FOV: 45 degrees; CFP; image size 2352x1568
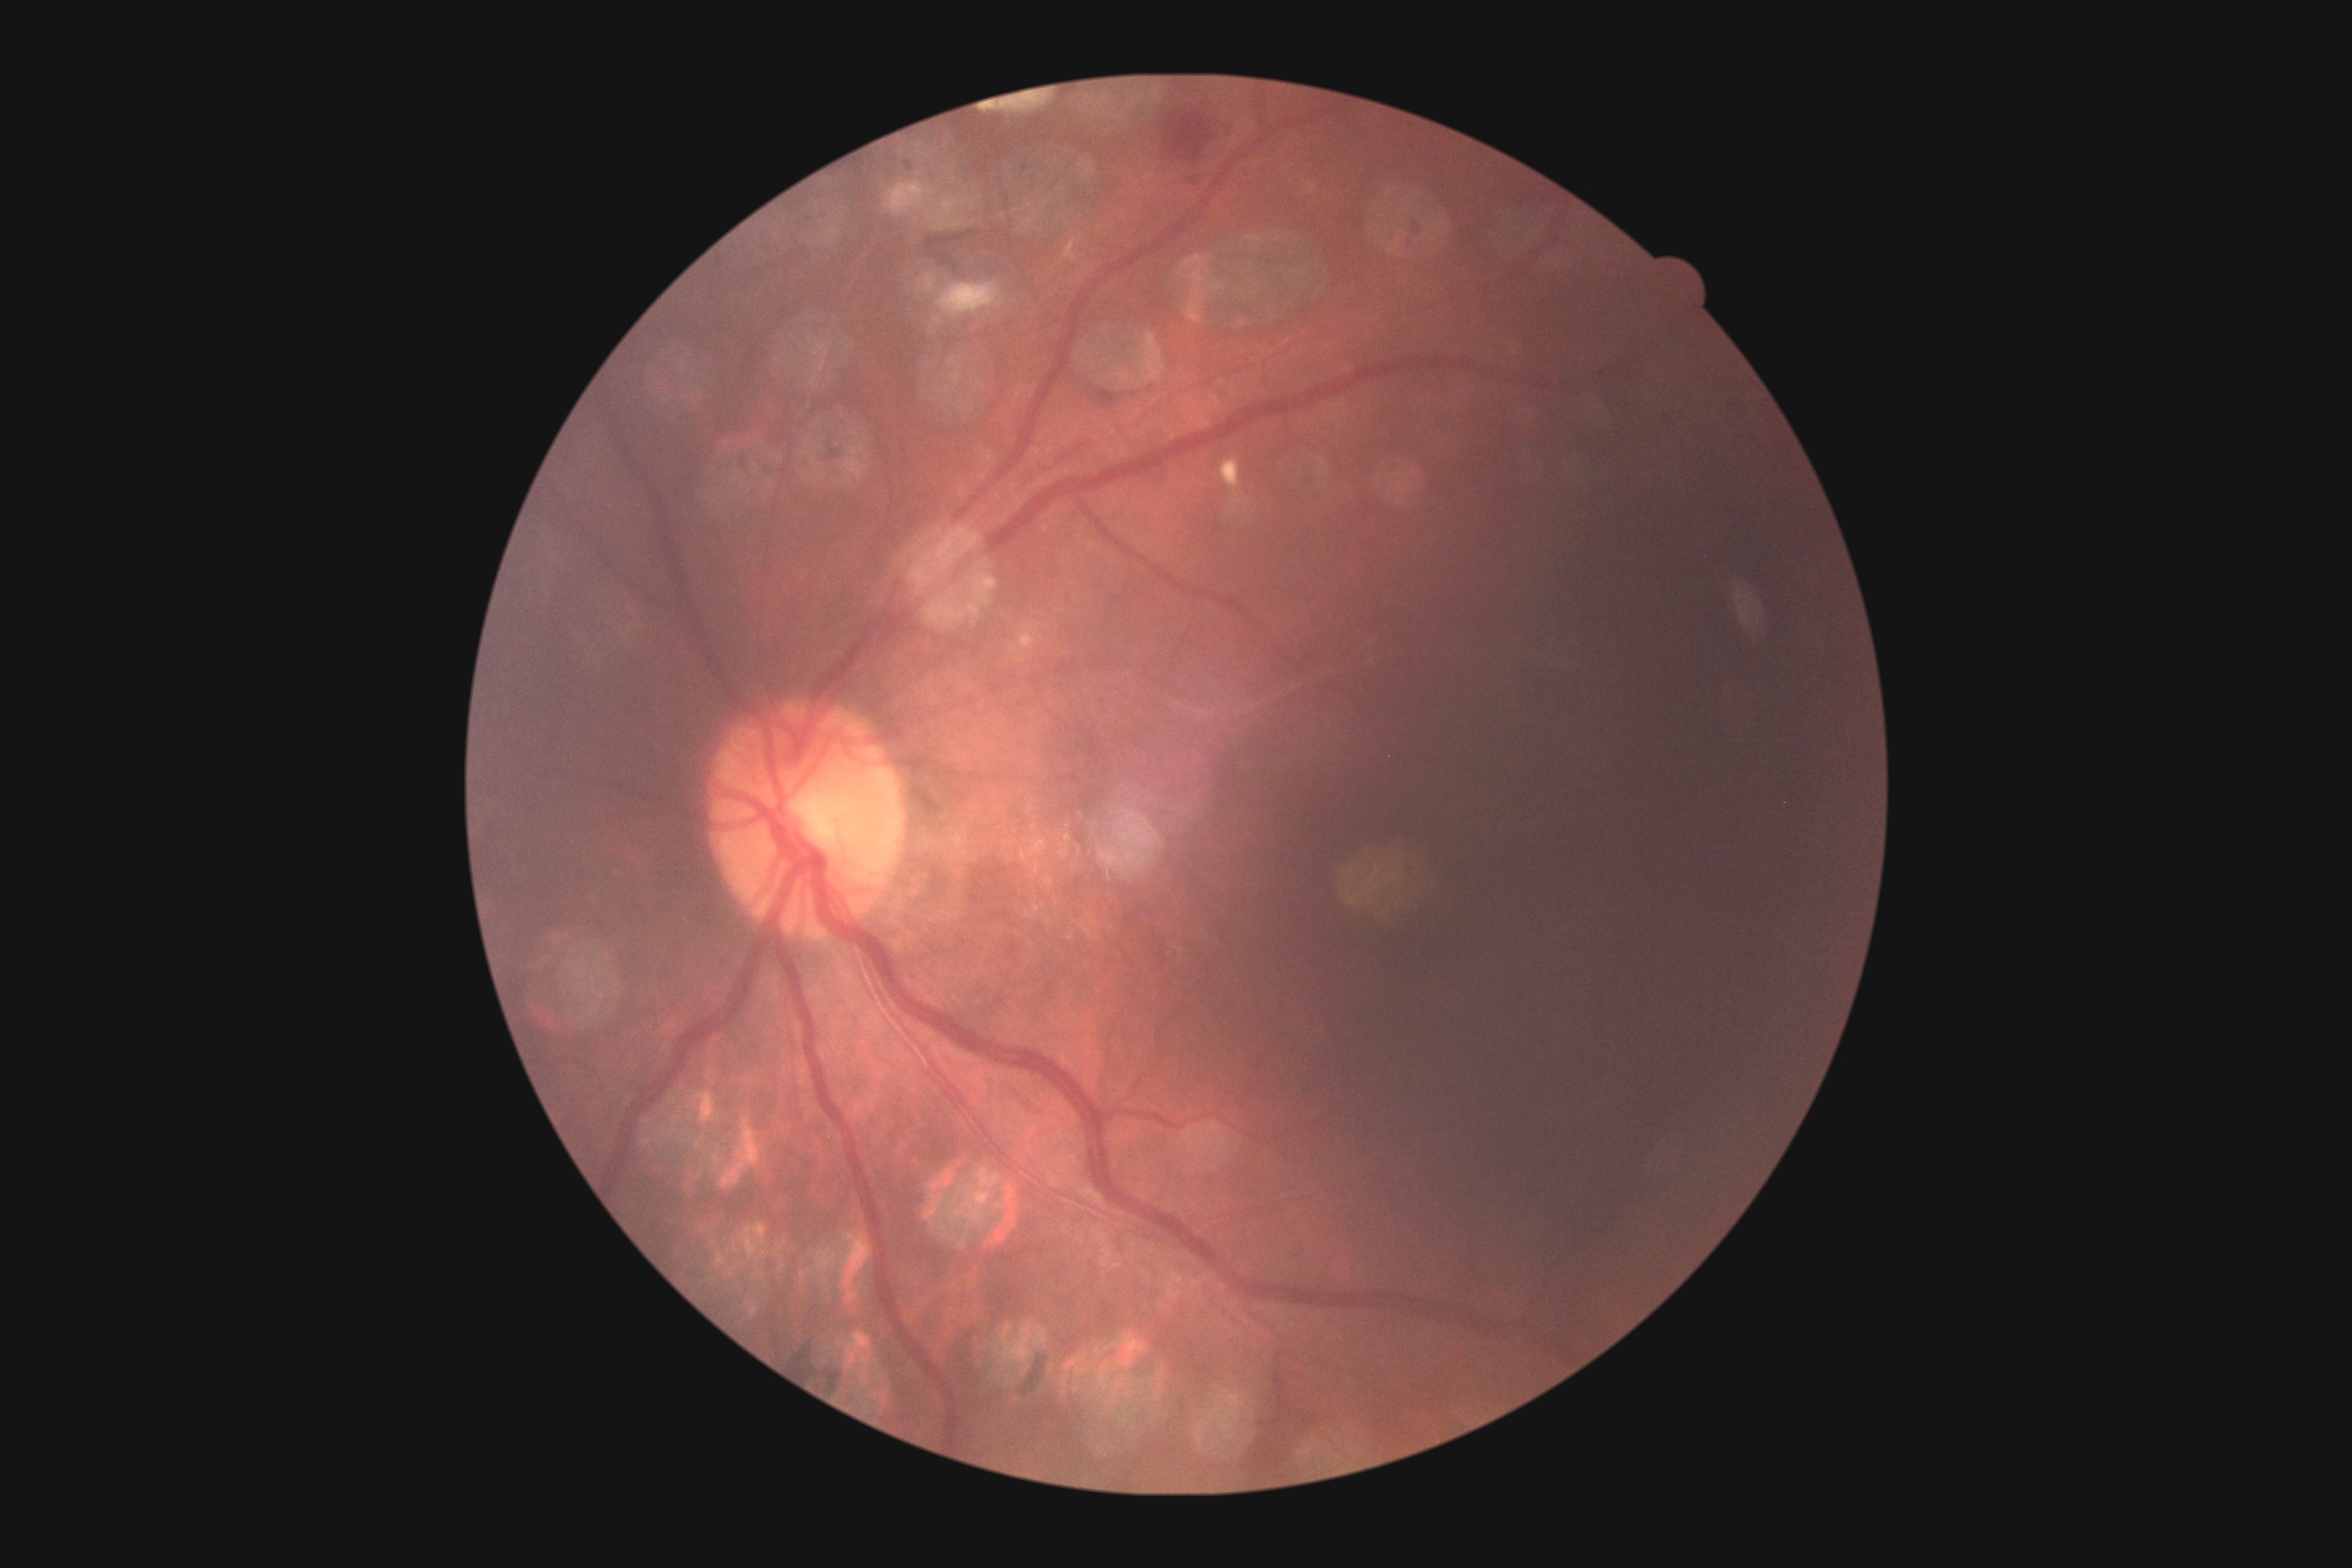 diabetic retinopathy (DR)@grade 2 (moderate NPDR) — more than just microaneurysms but less than severe NPDR.